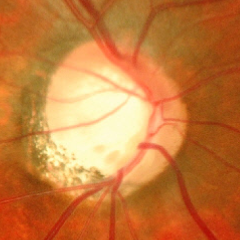

Glaucoma status: advanced glaucomatous optic neuropathy.